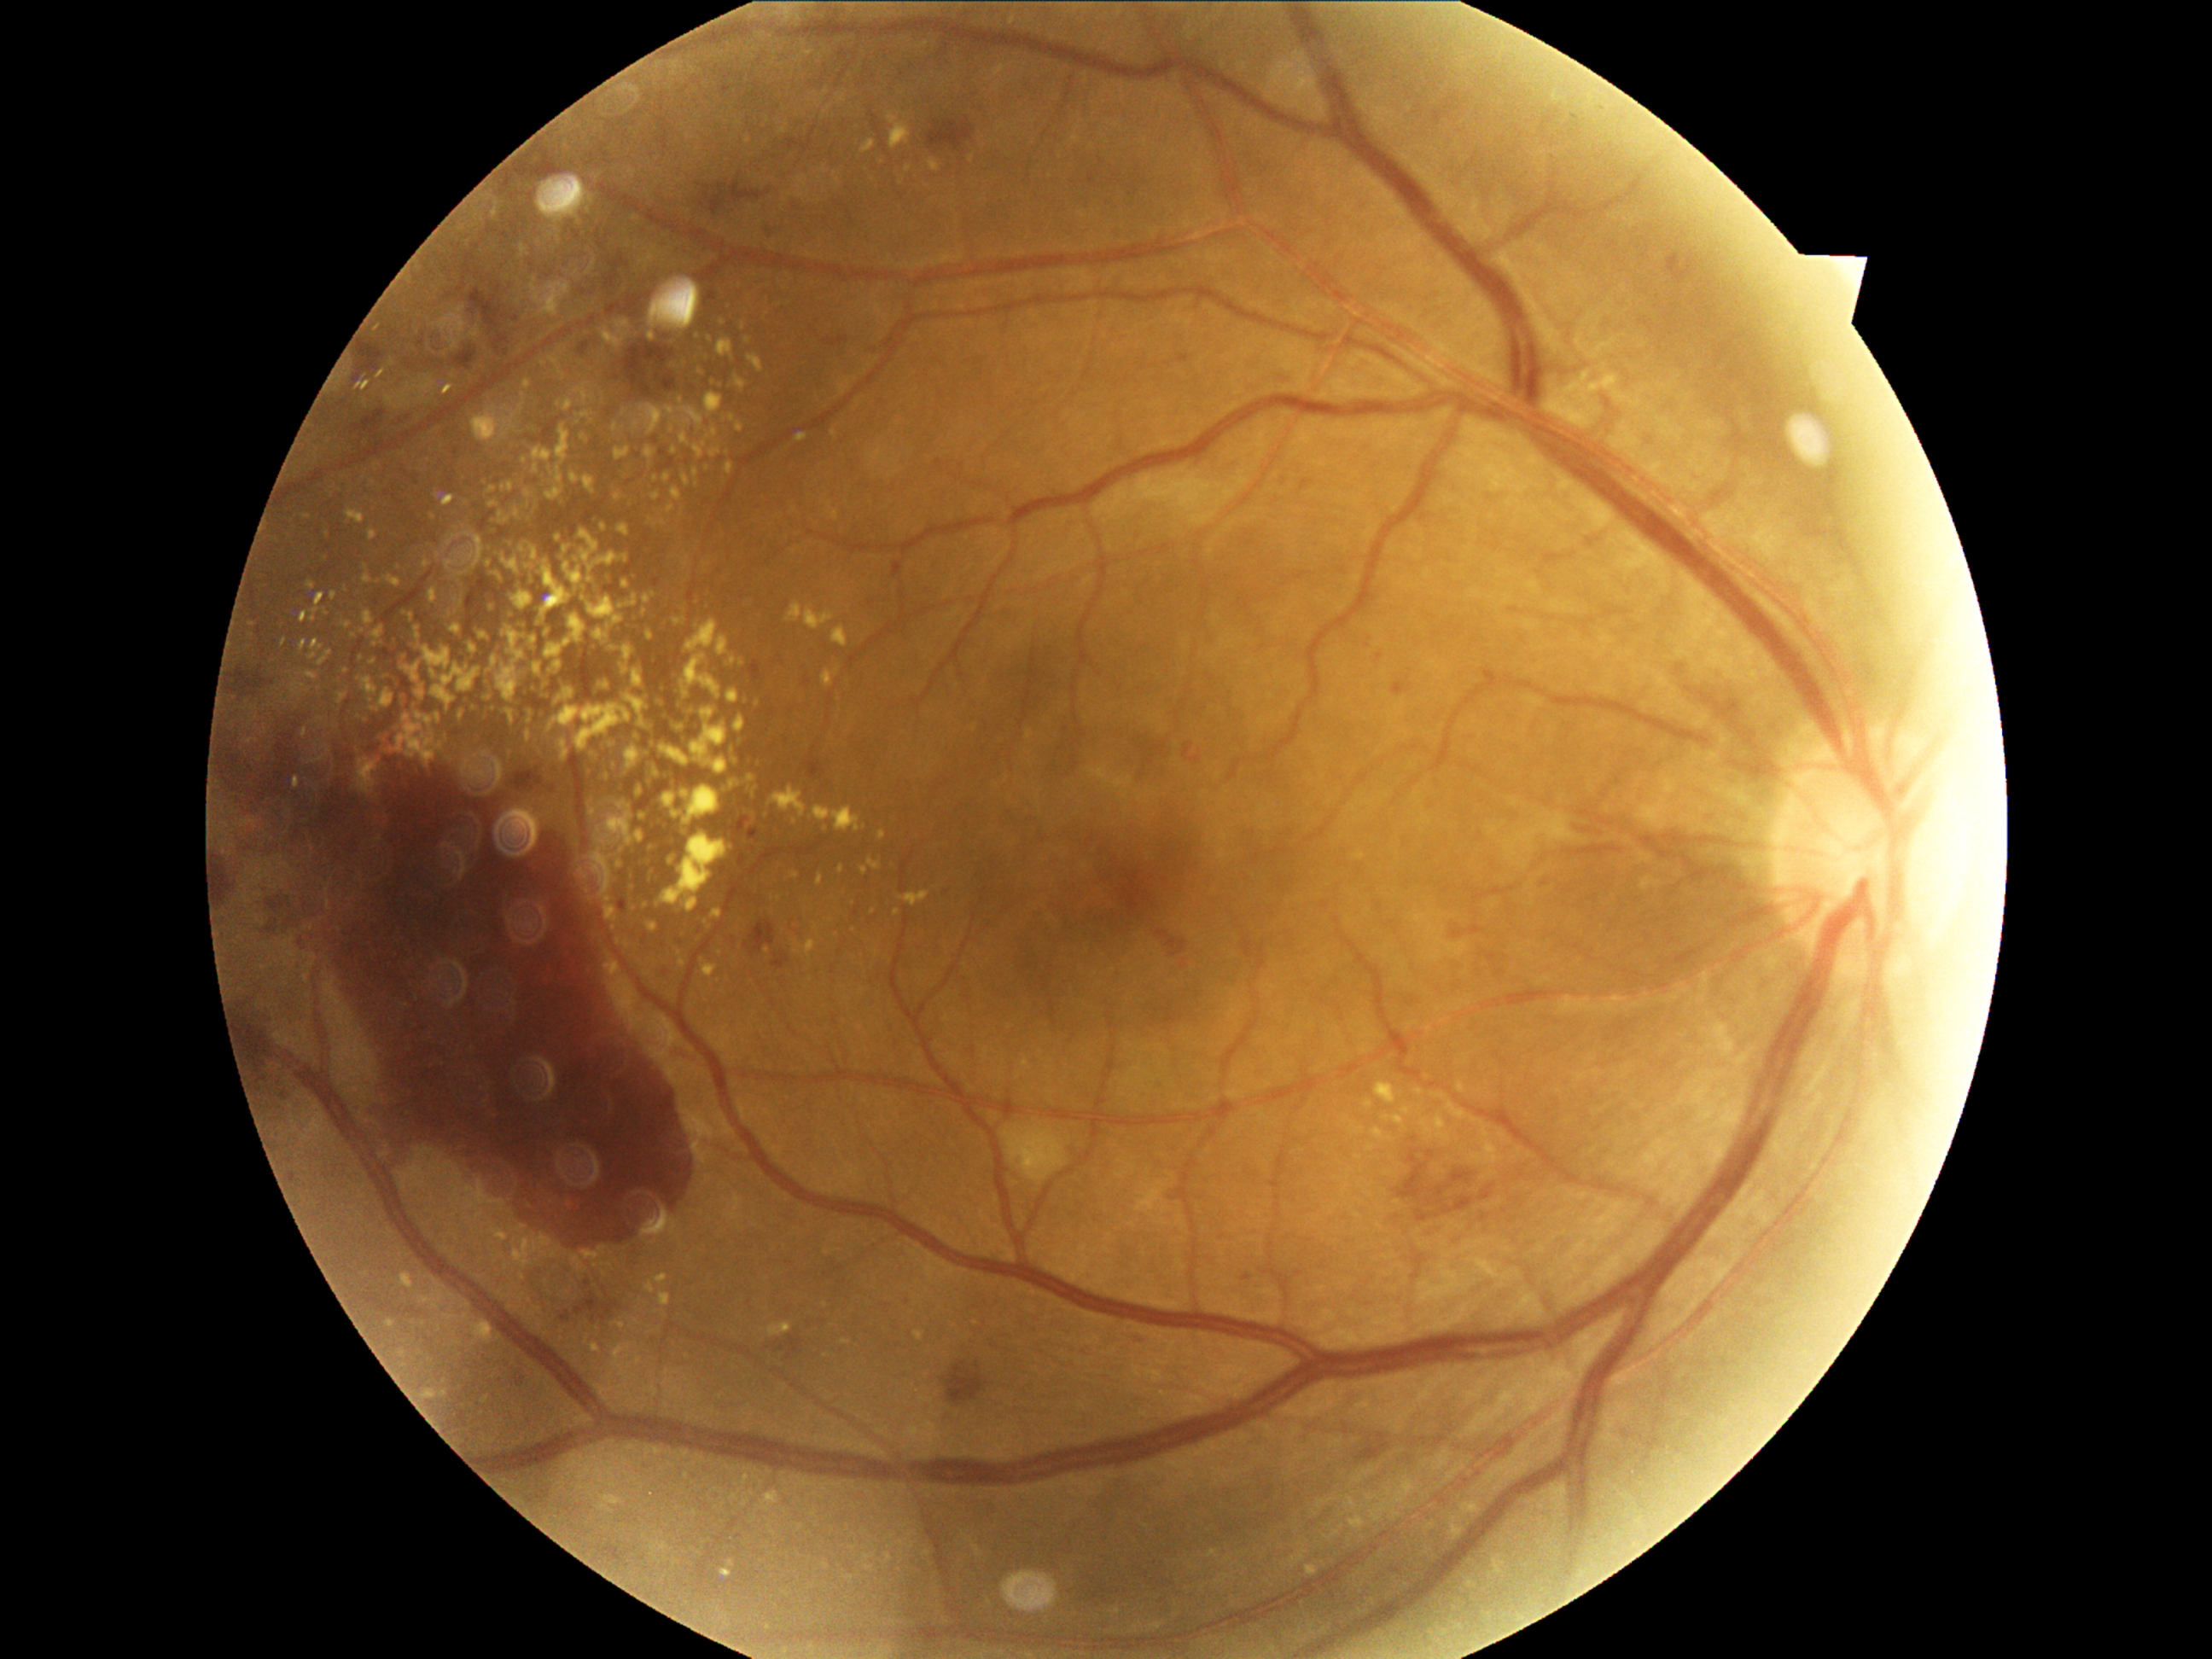
partial: true
dr_grade: 4
lesions:
  ex:
    - bbox(392, 716, 436, 764)
    - bbox(624, 639, 634, 661)
    - bbox(806, 941, 815, 953)
    - bbox(416, 685, 426, 701)
    - bbox(479, 632, 487, 641)
    - bbox(588, 576, 593, 585)
    - bbox(422, 765, 433, 771)
    - bbox(556, 426, 571, 463)
    - bbox(581, 412, 590, 419)
    - bbox(363, 574, 373, 586)
    - bbox(602, 574, 608, 585)
    - bbox(905, 892, 929, 905)
  ex_small_centers:
    - (400; 569)
    - (526; 397)
    - (491; 608)
    - (583; 438)
    - (709; 355)
    - (652; 782)
    - (468; 702)